Fundus photo · acquired with a Remidio FOP fundus camera.
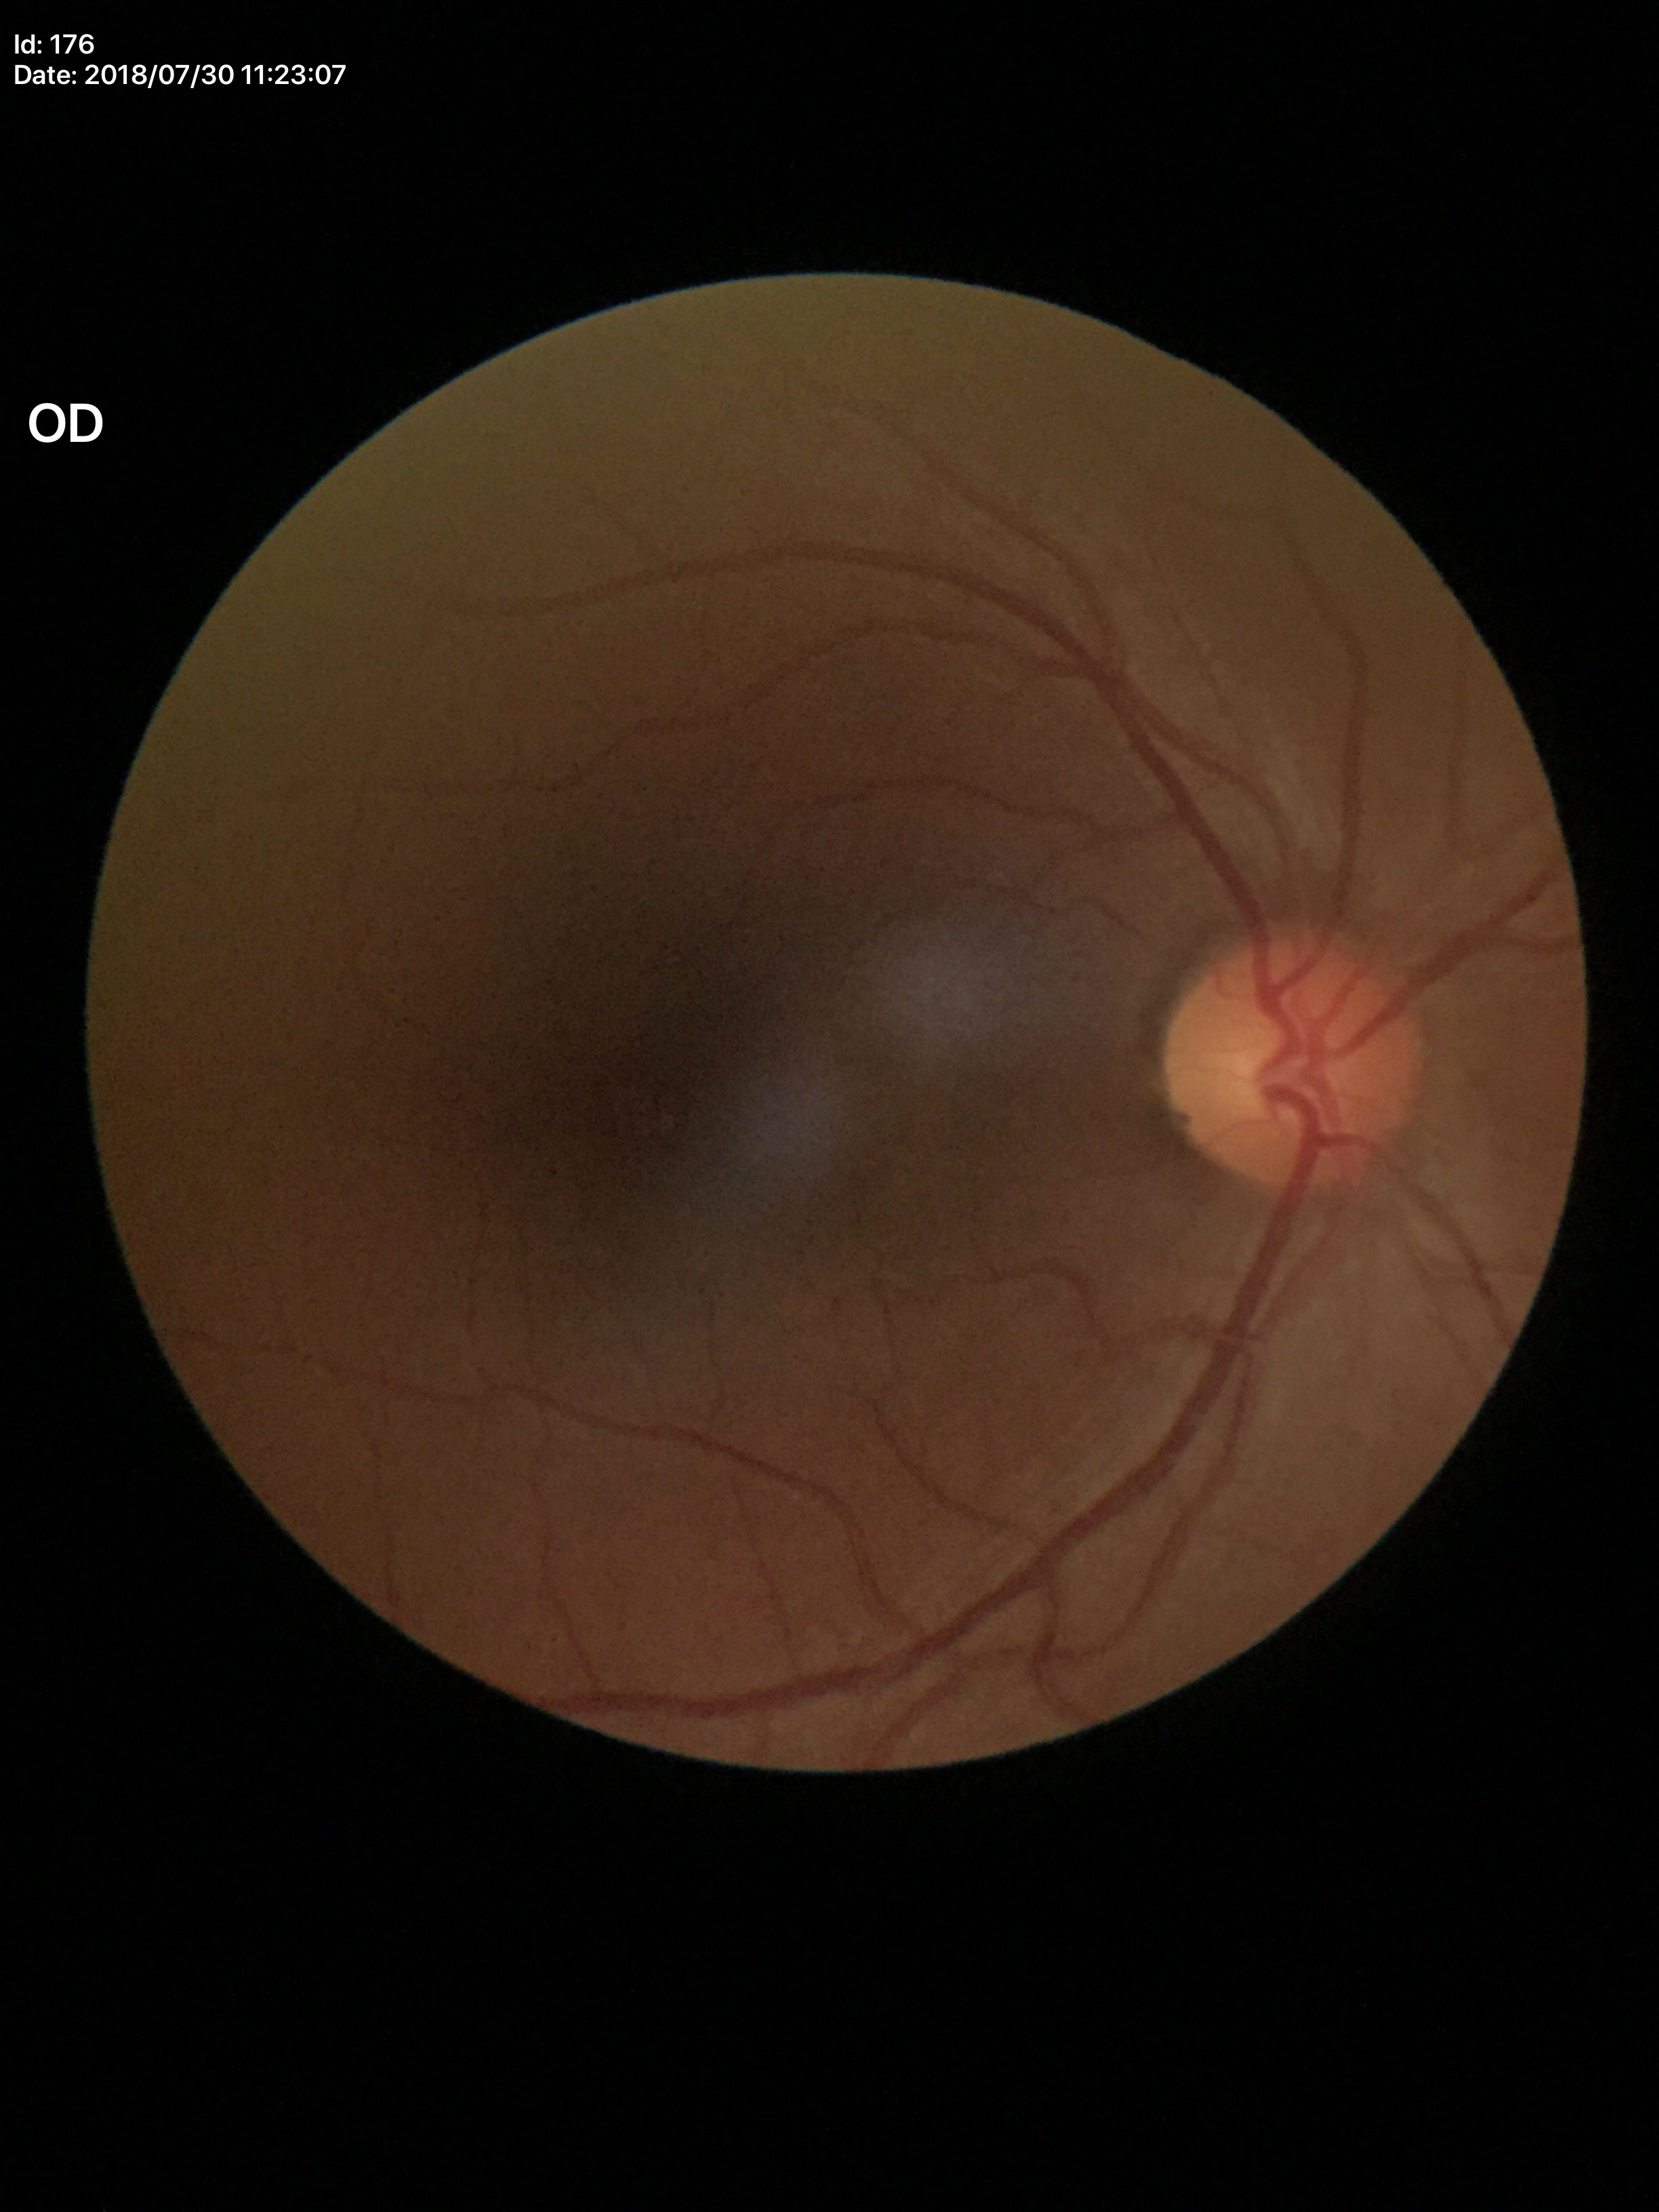

Glaucoma evaluation: not suspect | vertical cup-disc ratio: 0.45